Color fundus image:
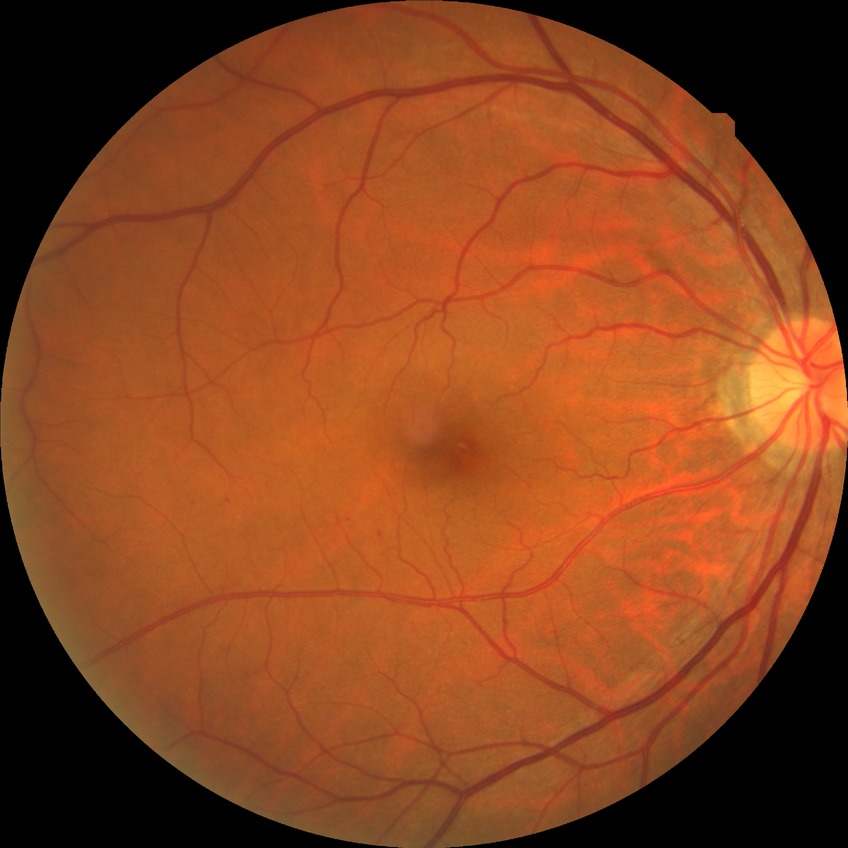
Davis stage is SDR.